Wide-field retinal mosaic image — 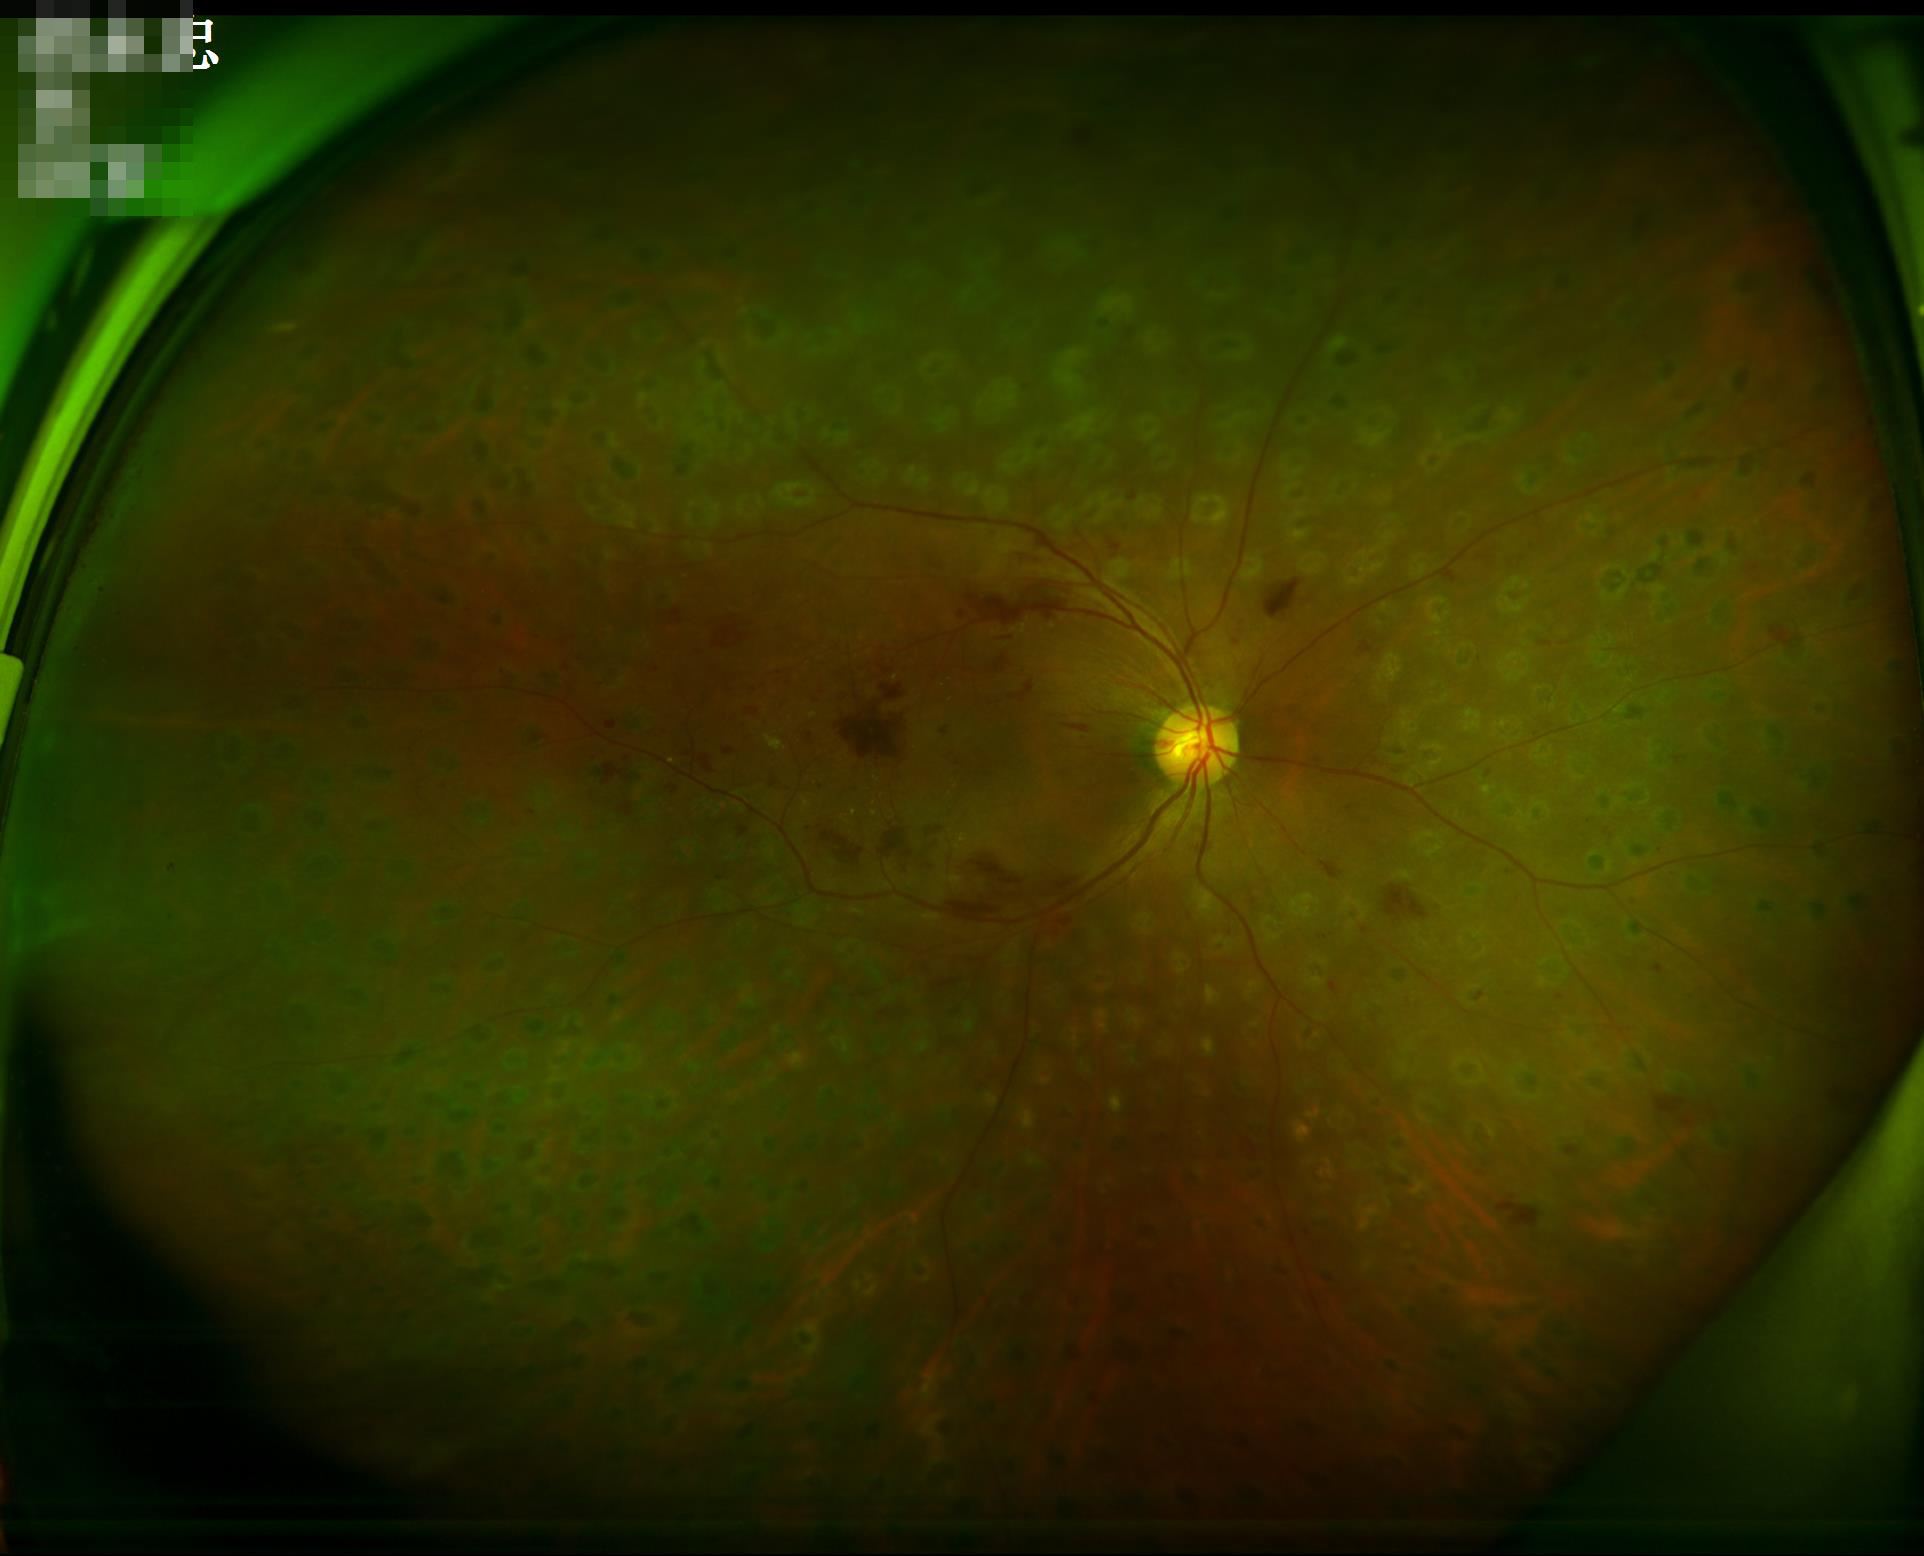

Contrast = wide intensity range, structures distinguishable; Clarity = clear with no noticeable blur; Overall quality = good, gradable.